130° field of view (Clarity RetCam 3); 640x480px; infant wide-field fundus photograph:
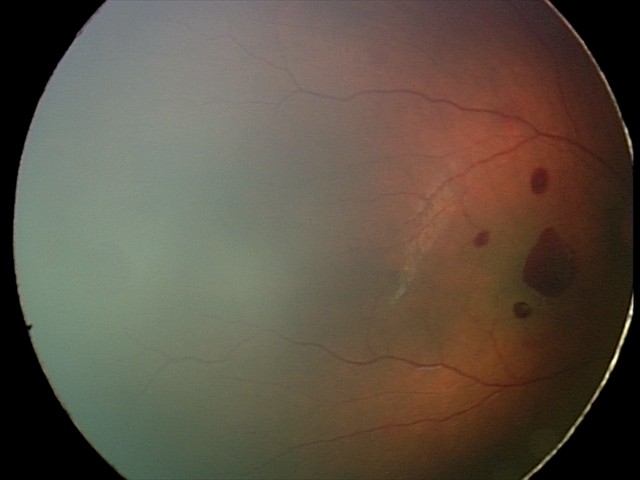
Assessment: retinal hemorrhages.